45° FOV — 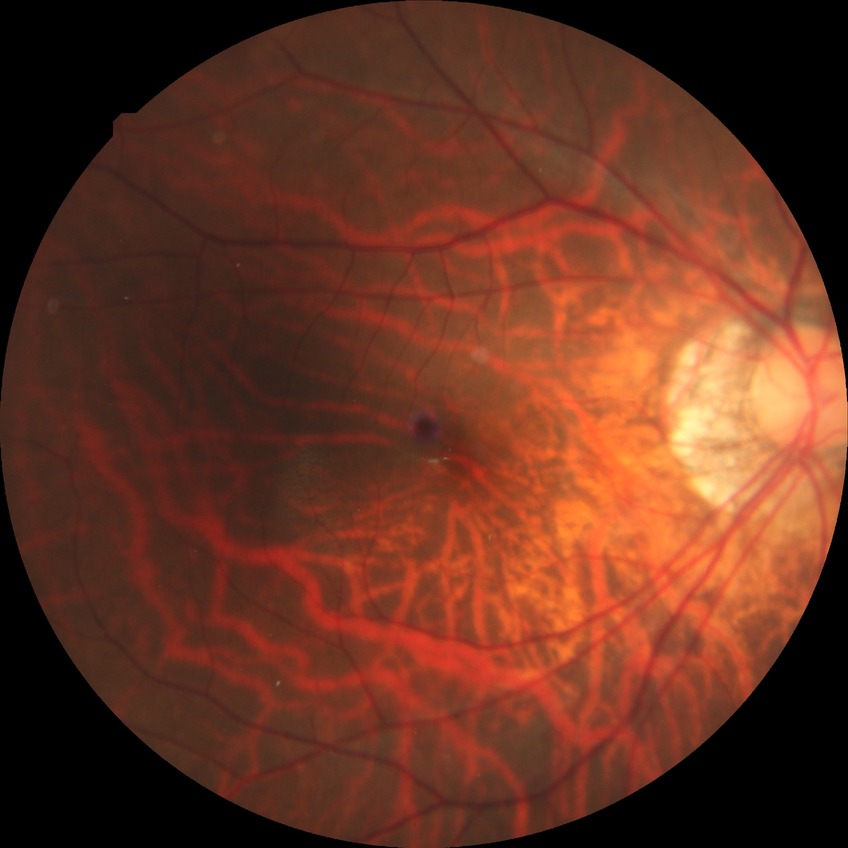

Retinopathy grade: no diabetic retinopathy.